FOV: 45 degrees. Captured on a Canon CR-1 fundus camera
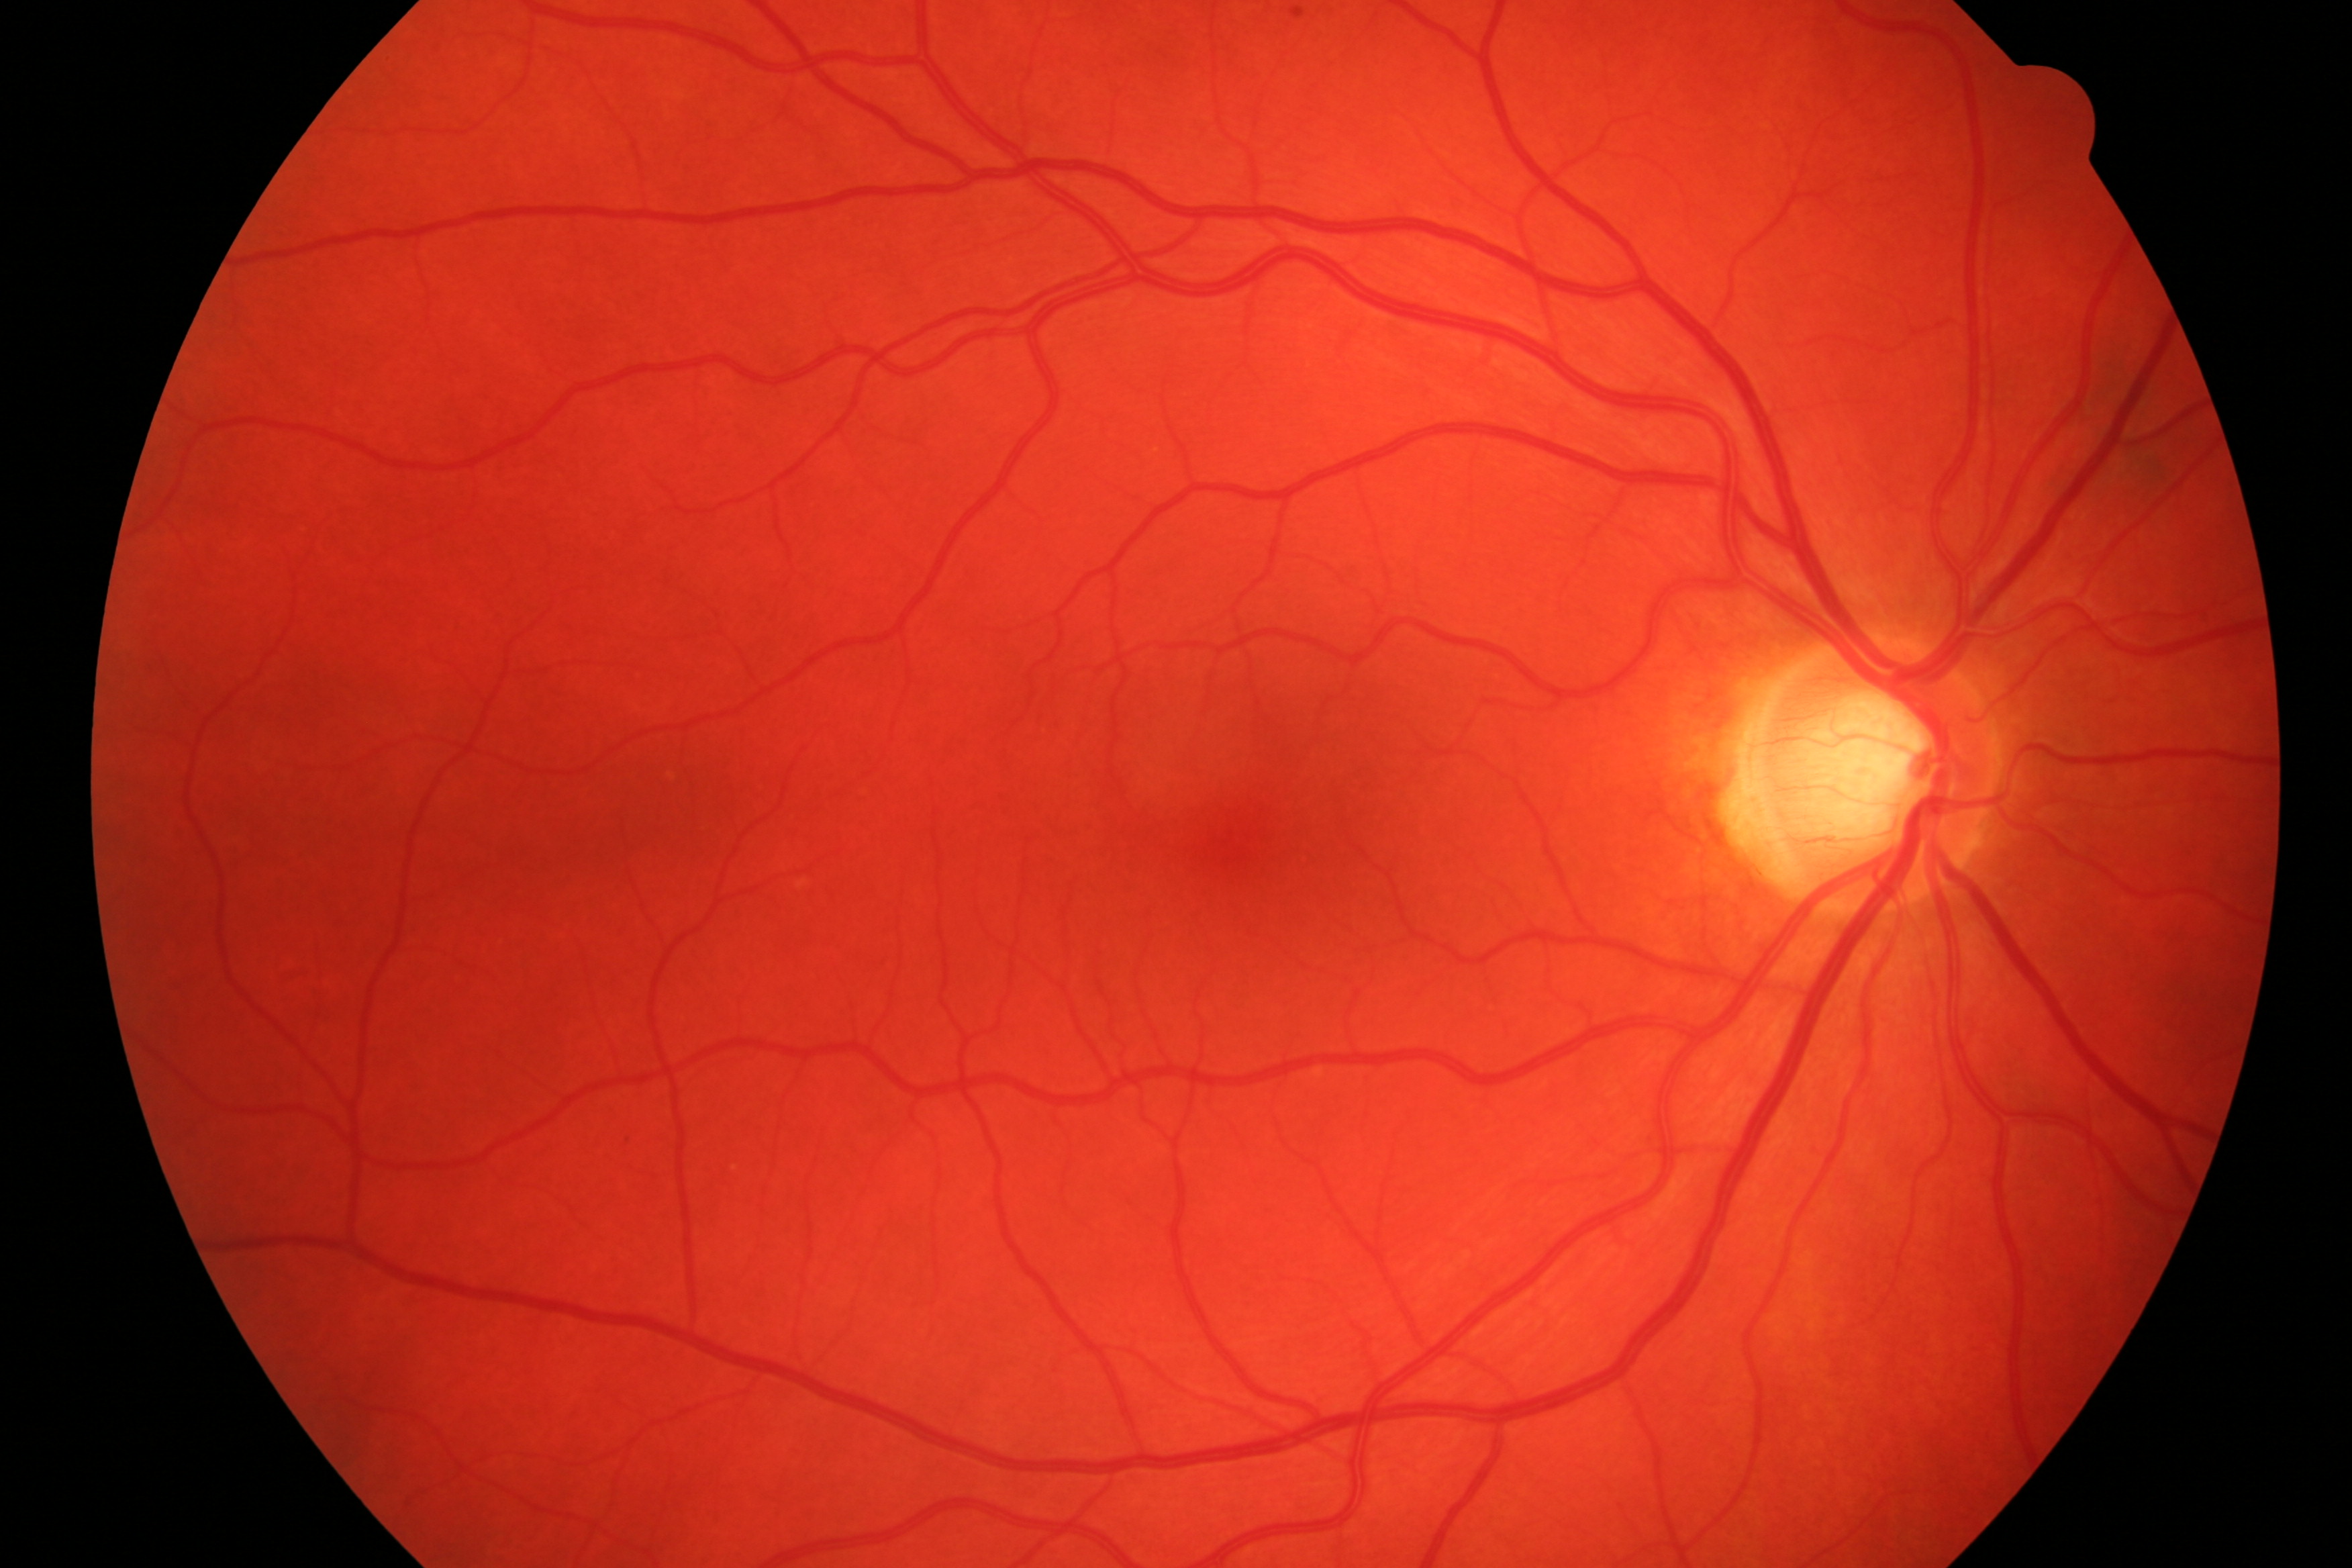 Pathology: no diabetic retinopathy or glaucomatous changes.